Color fundus photograph: 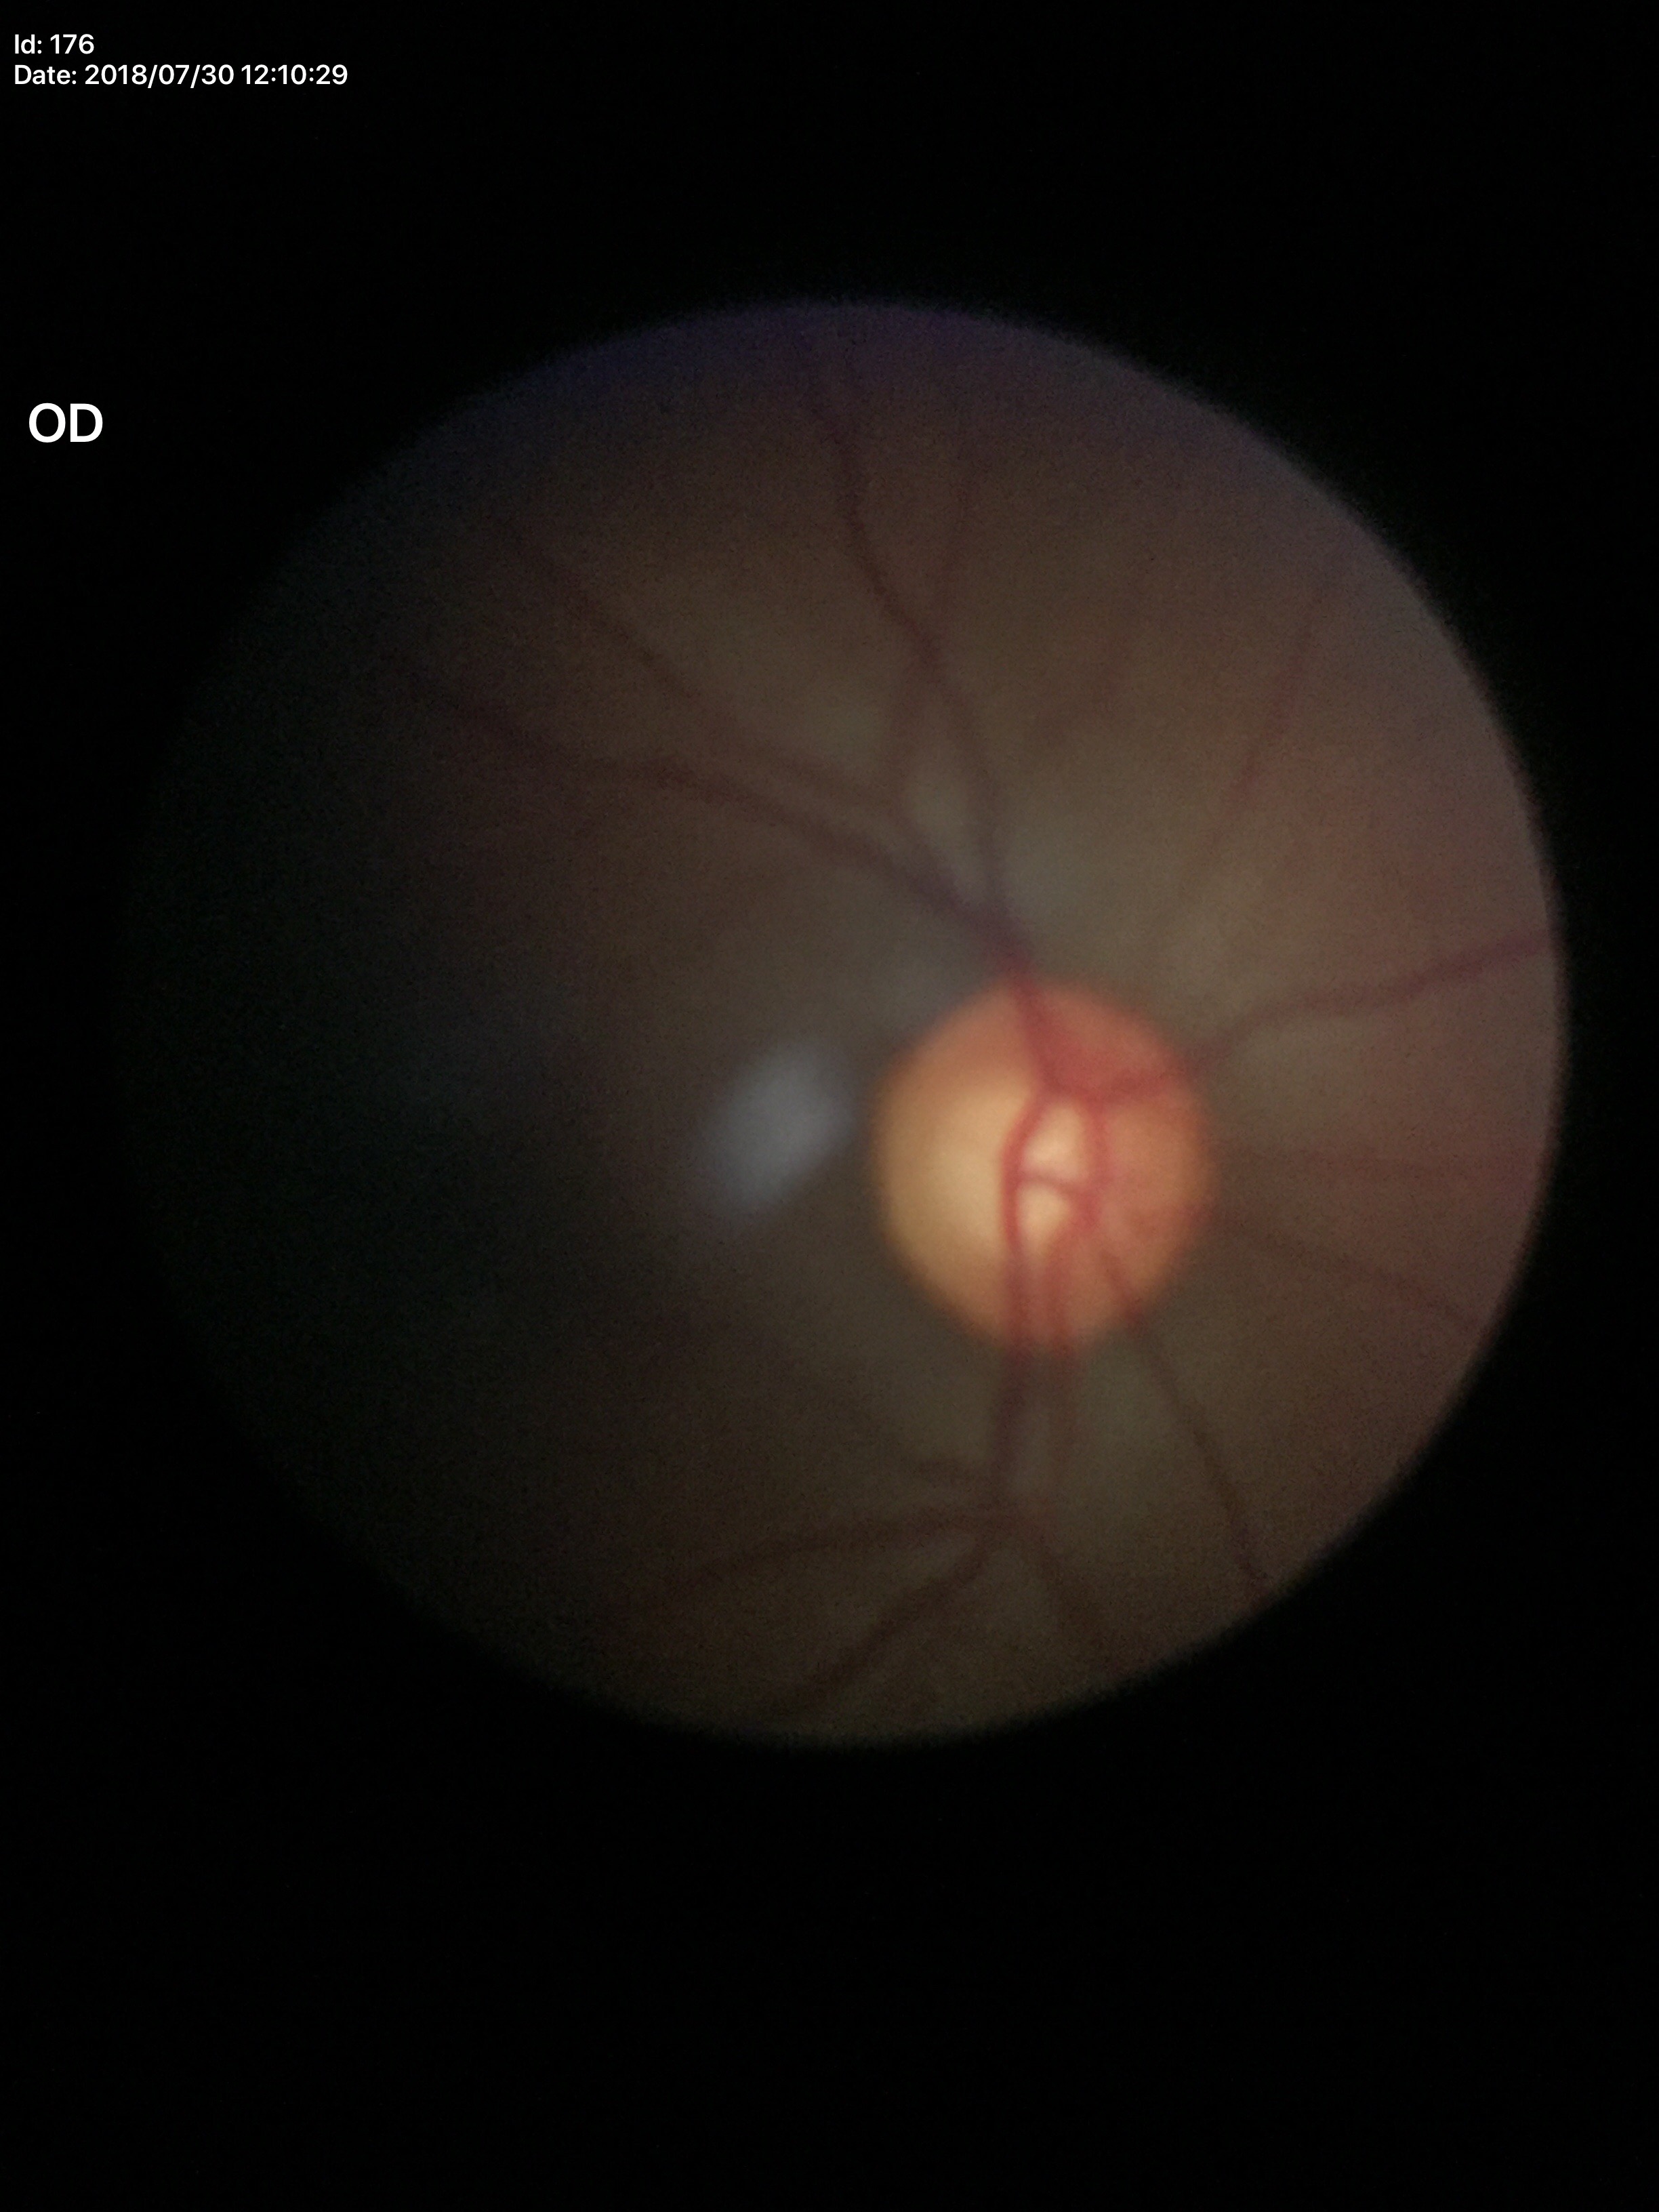
VCDR: 0.55. HCDR of 0.58. Negative for glaucoma suspicion (one of five ophthalmologists flagged glaucoma suspect).